Fundus photo:
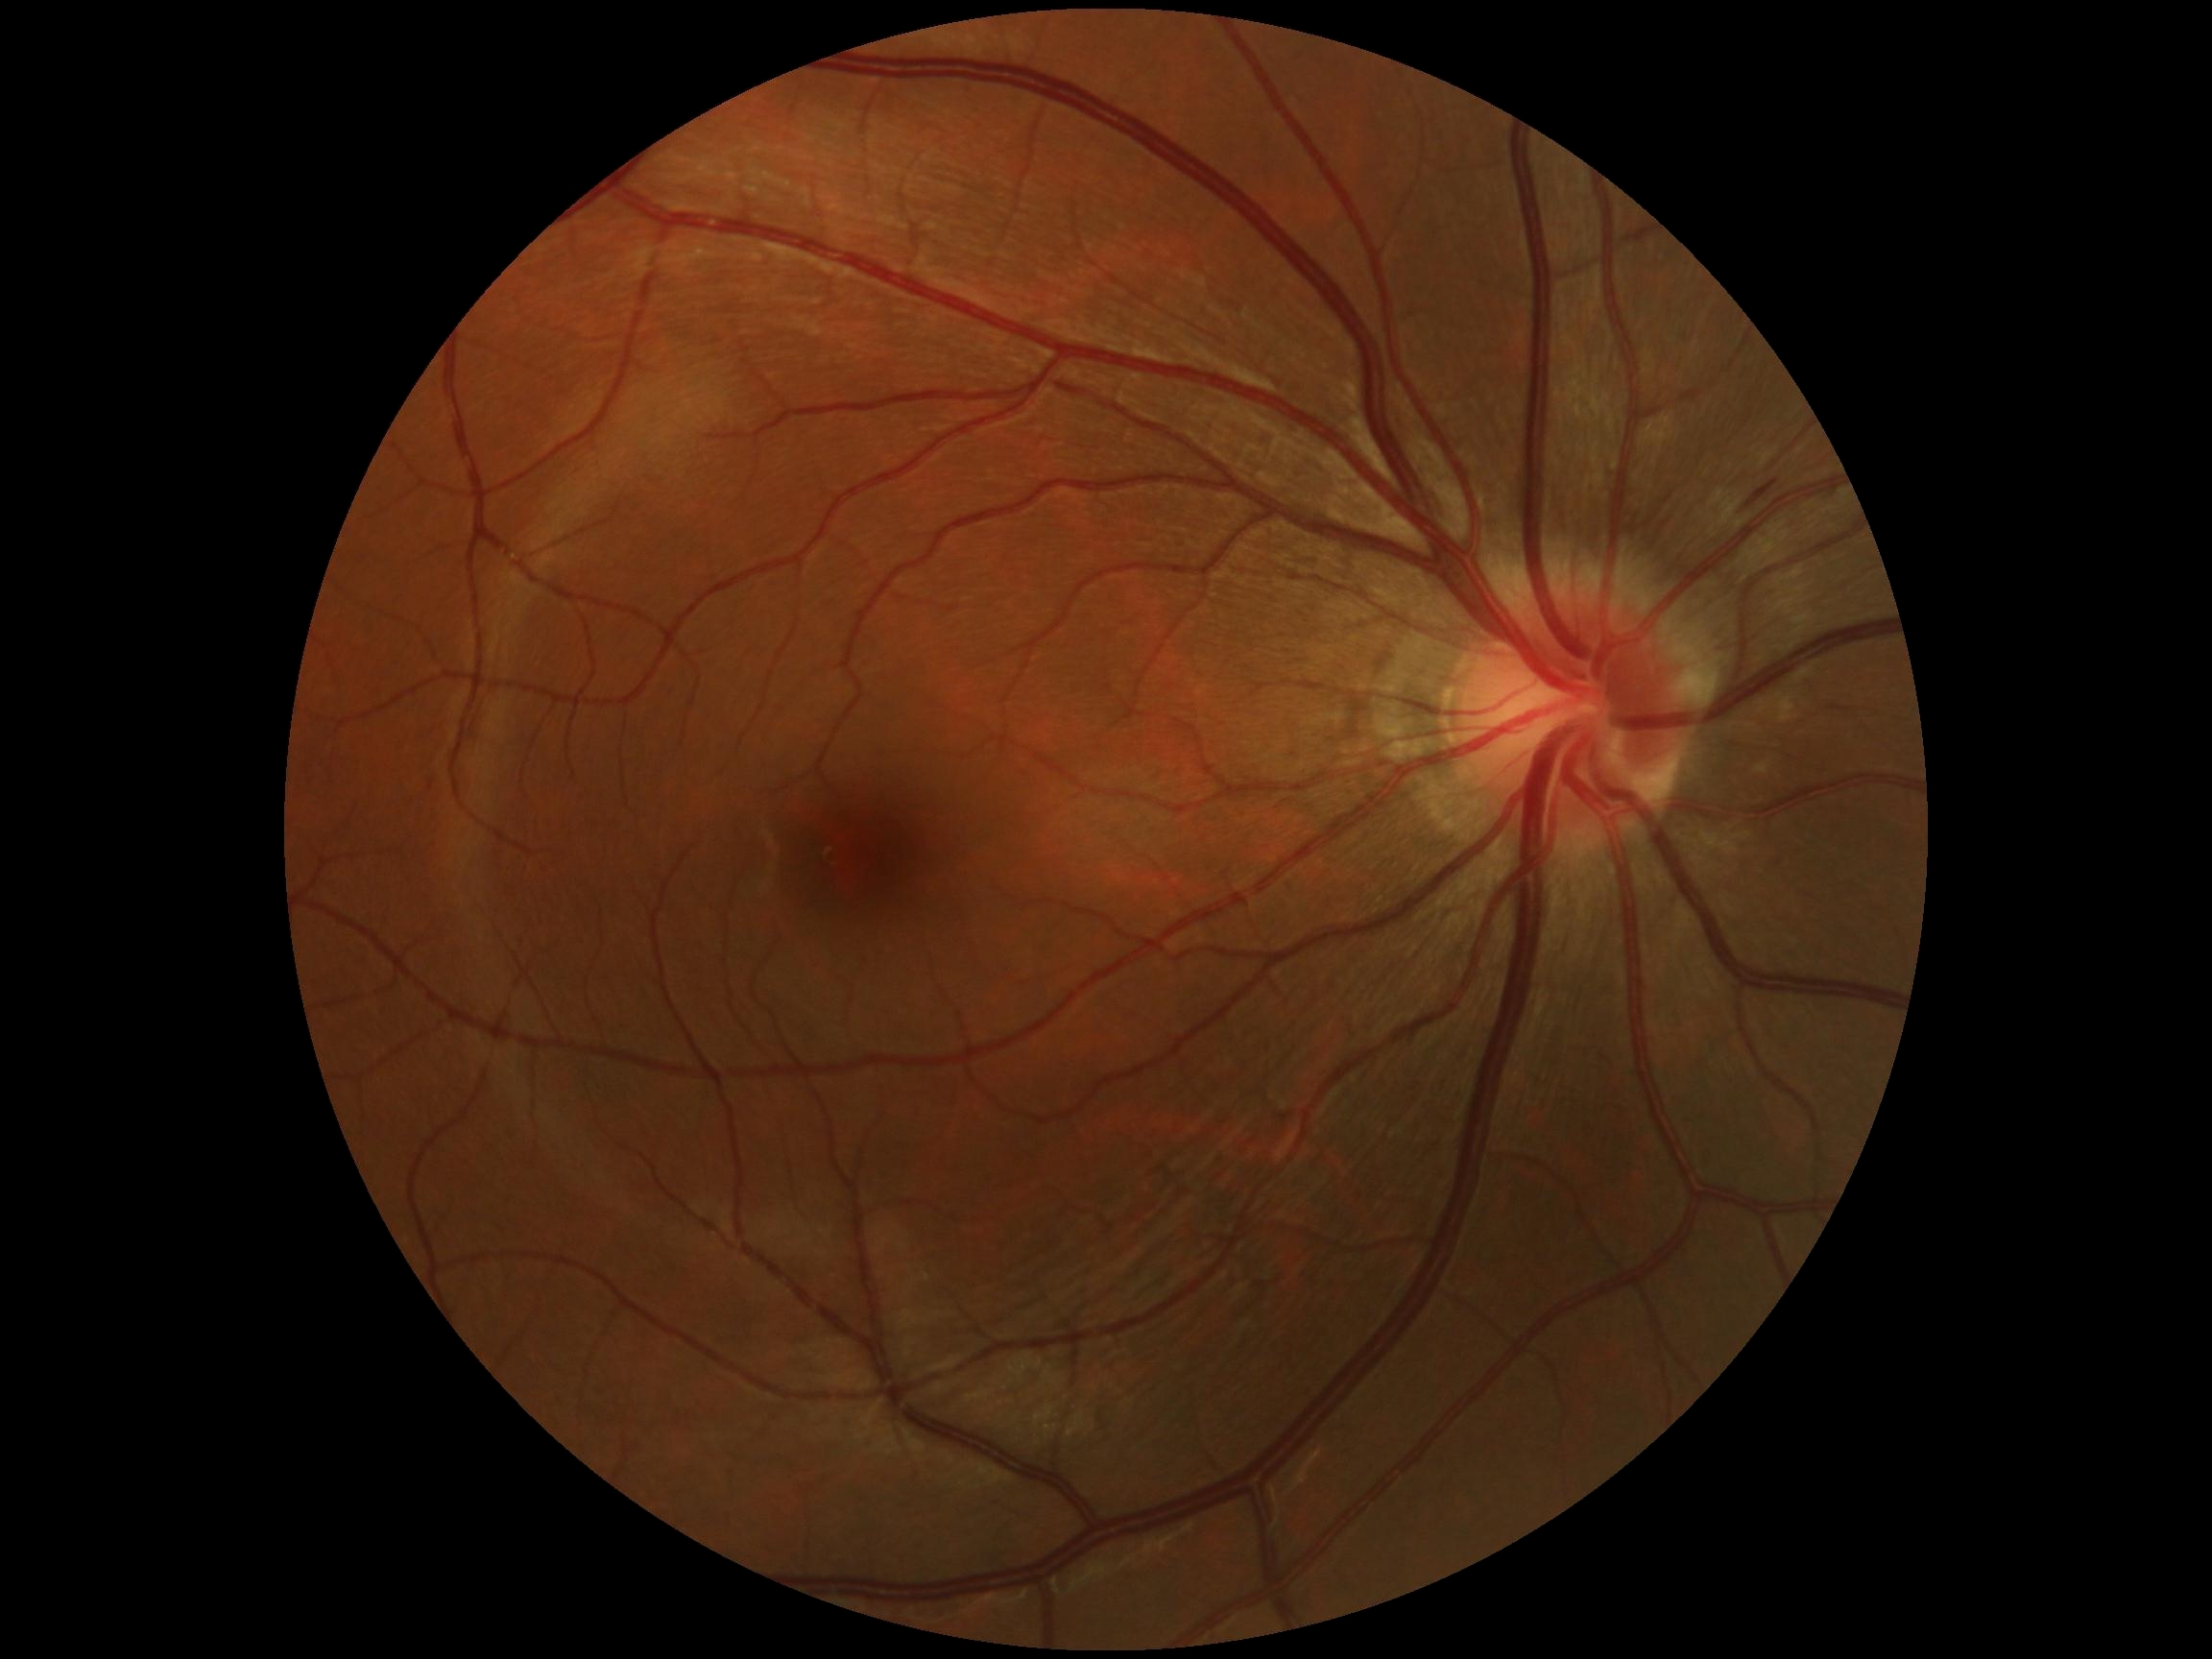 DR grade: 2 (moderate NPDR).